2212x1659 · FOV: 45 degrees — 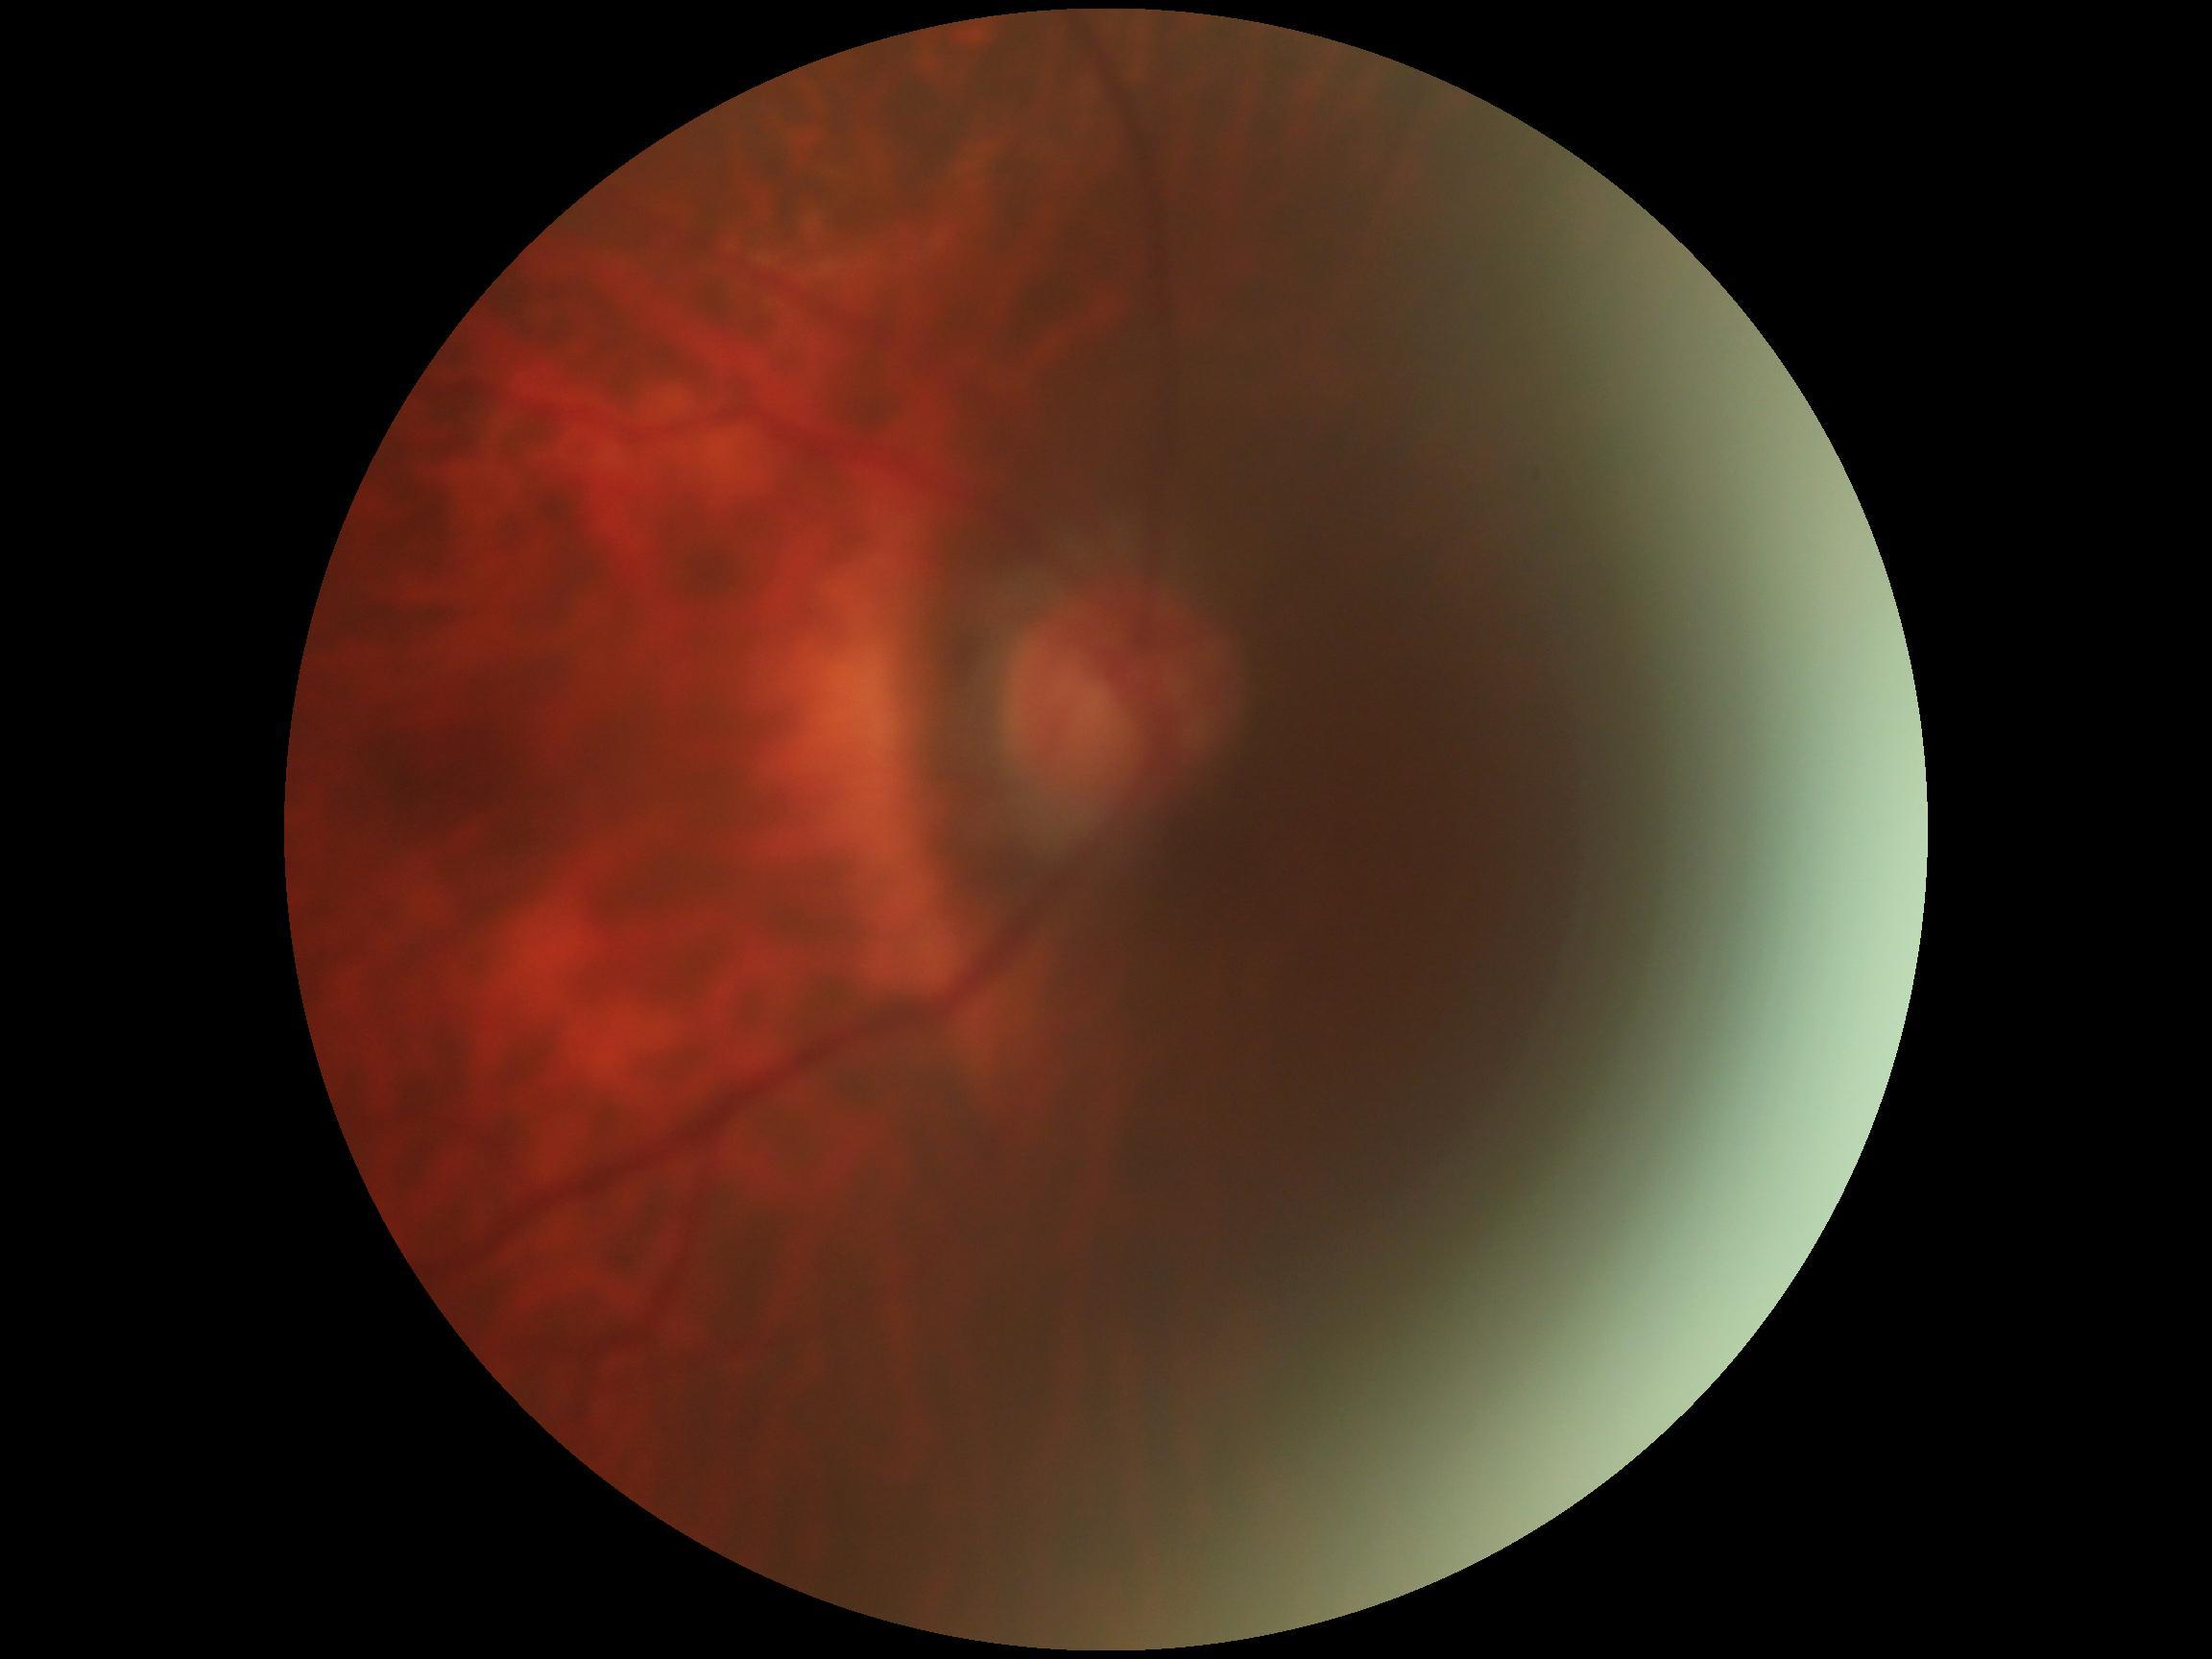 DR severity@ungradable.